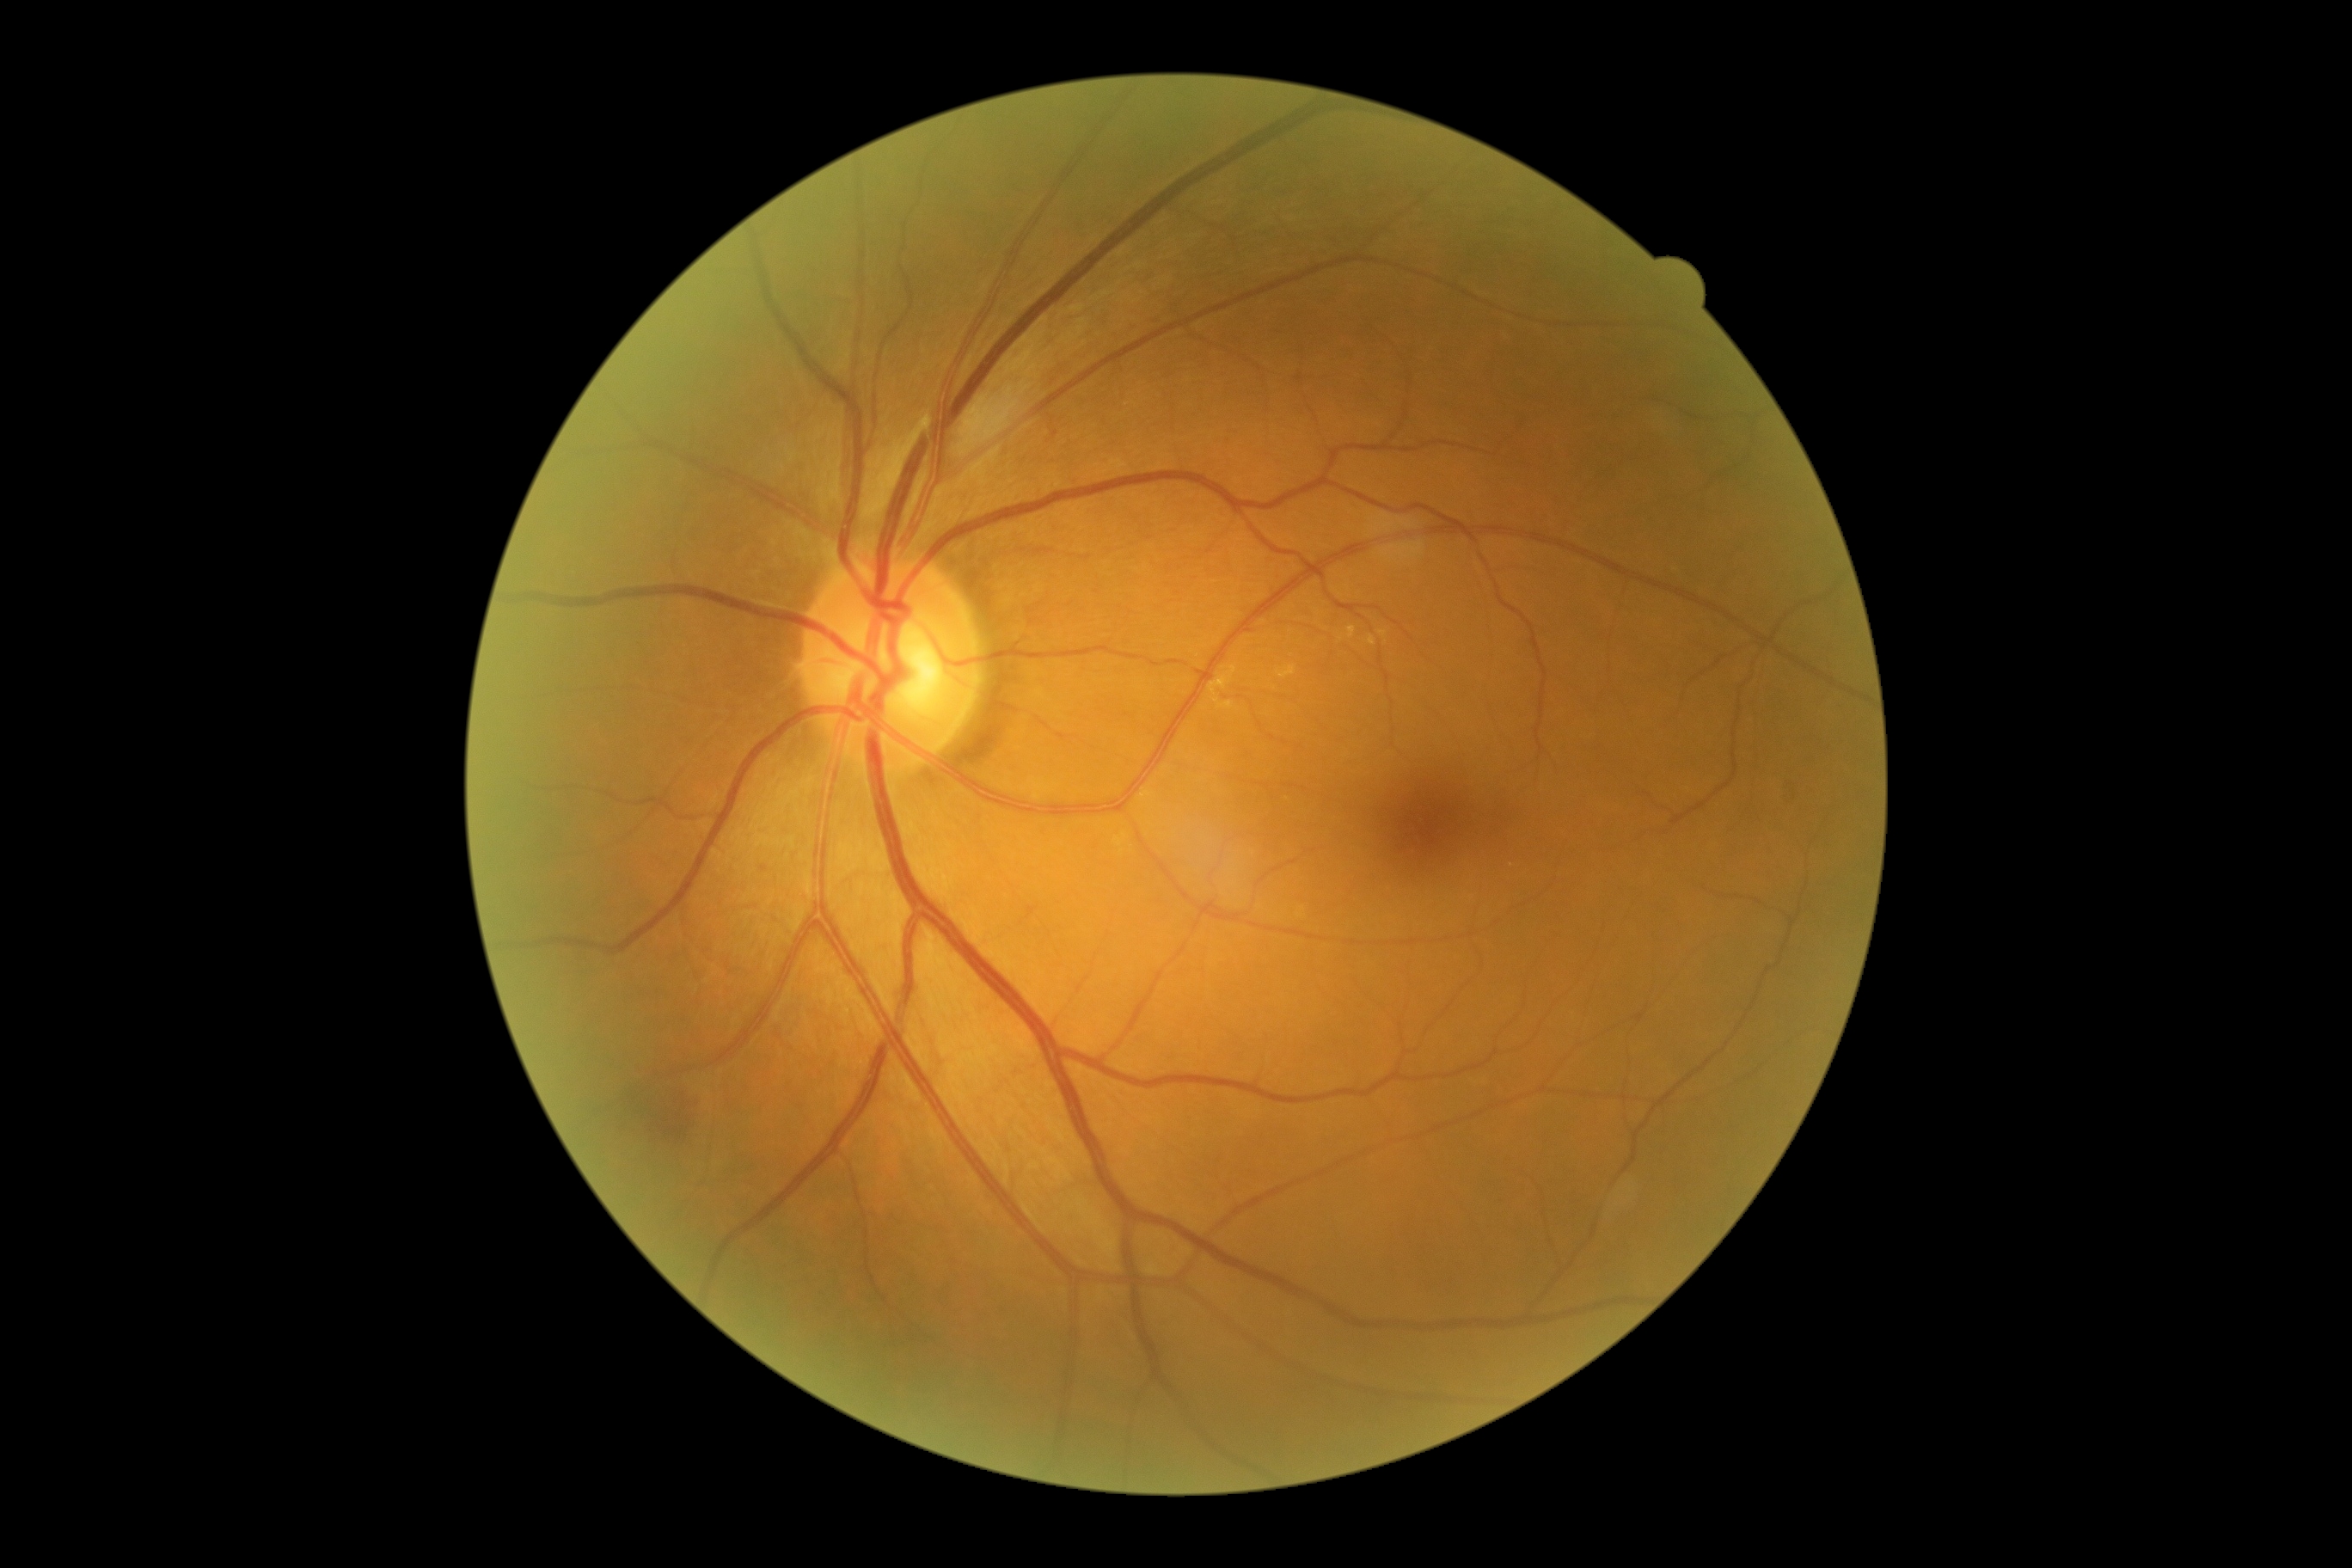

Diabetic retinopathy (DR): moderate non-proliferative diabetic retinopathy (grade 2). Hemorrhages (HEs) are present, including at box=[625, 1089, 702, 1148]. No microaneurysms (MAs) identified. No soft exudates (SEs) identified. No hard exudates (EXs) identified.